Wide-field fundus image from infant ROP screening · Phoenix ICON, 100° FOV:
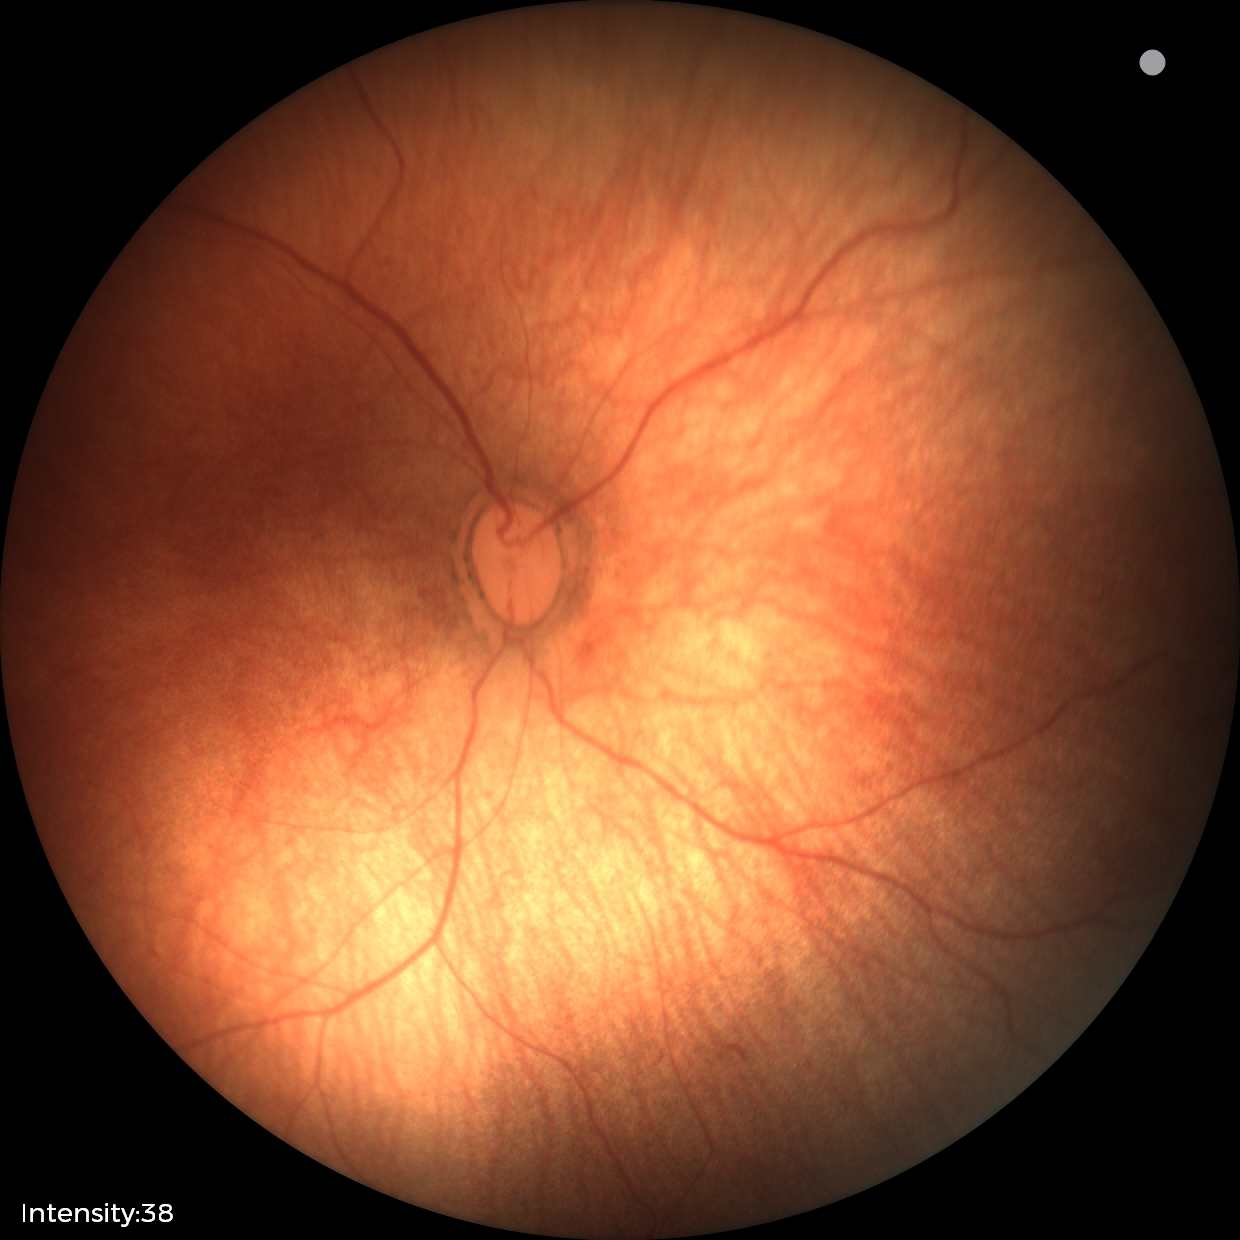 Physiological retinal appearance for postconceptual age.